Fundus photo.
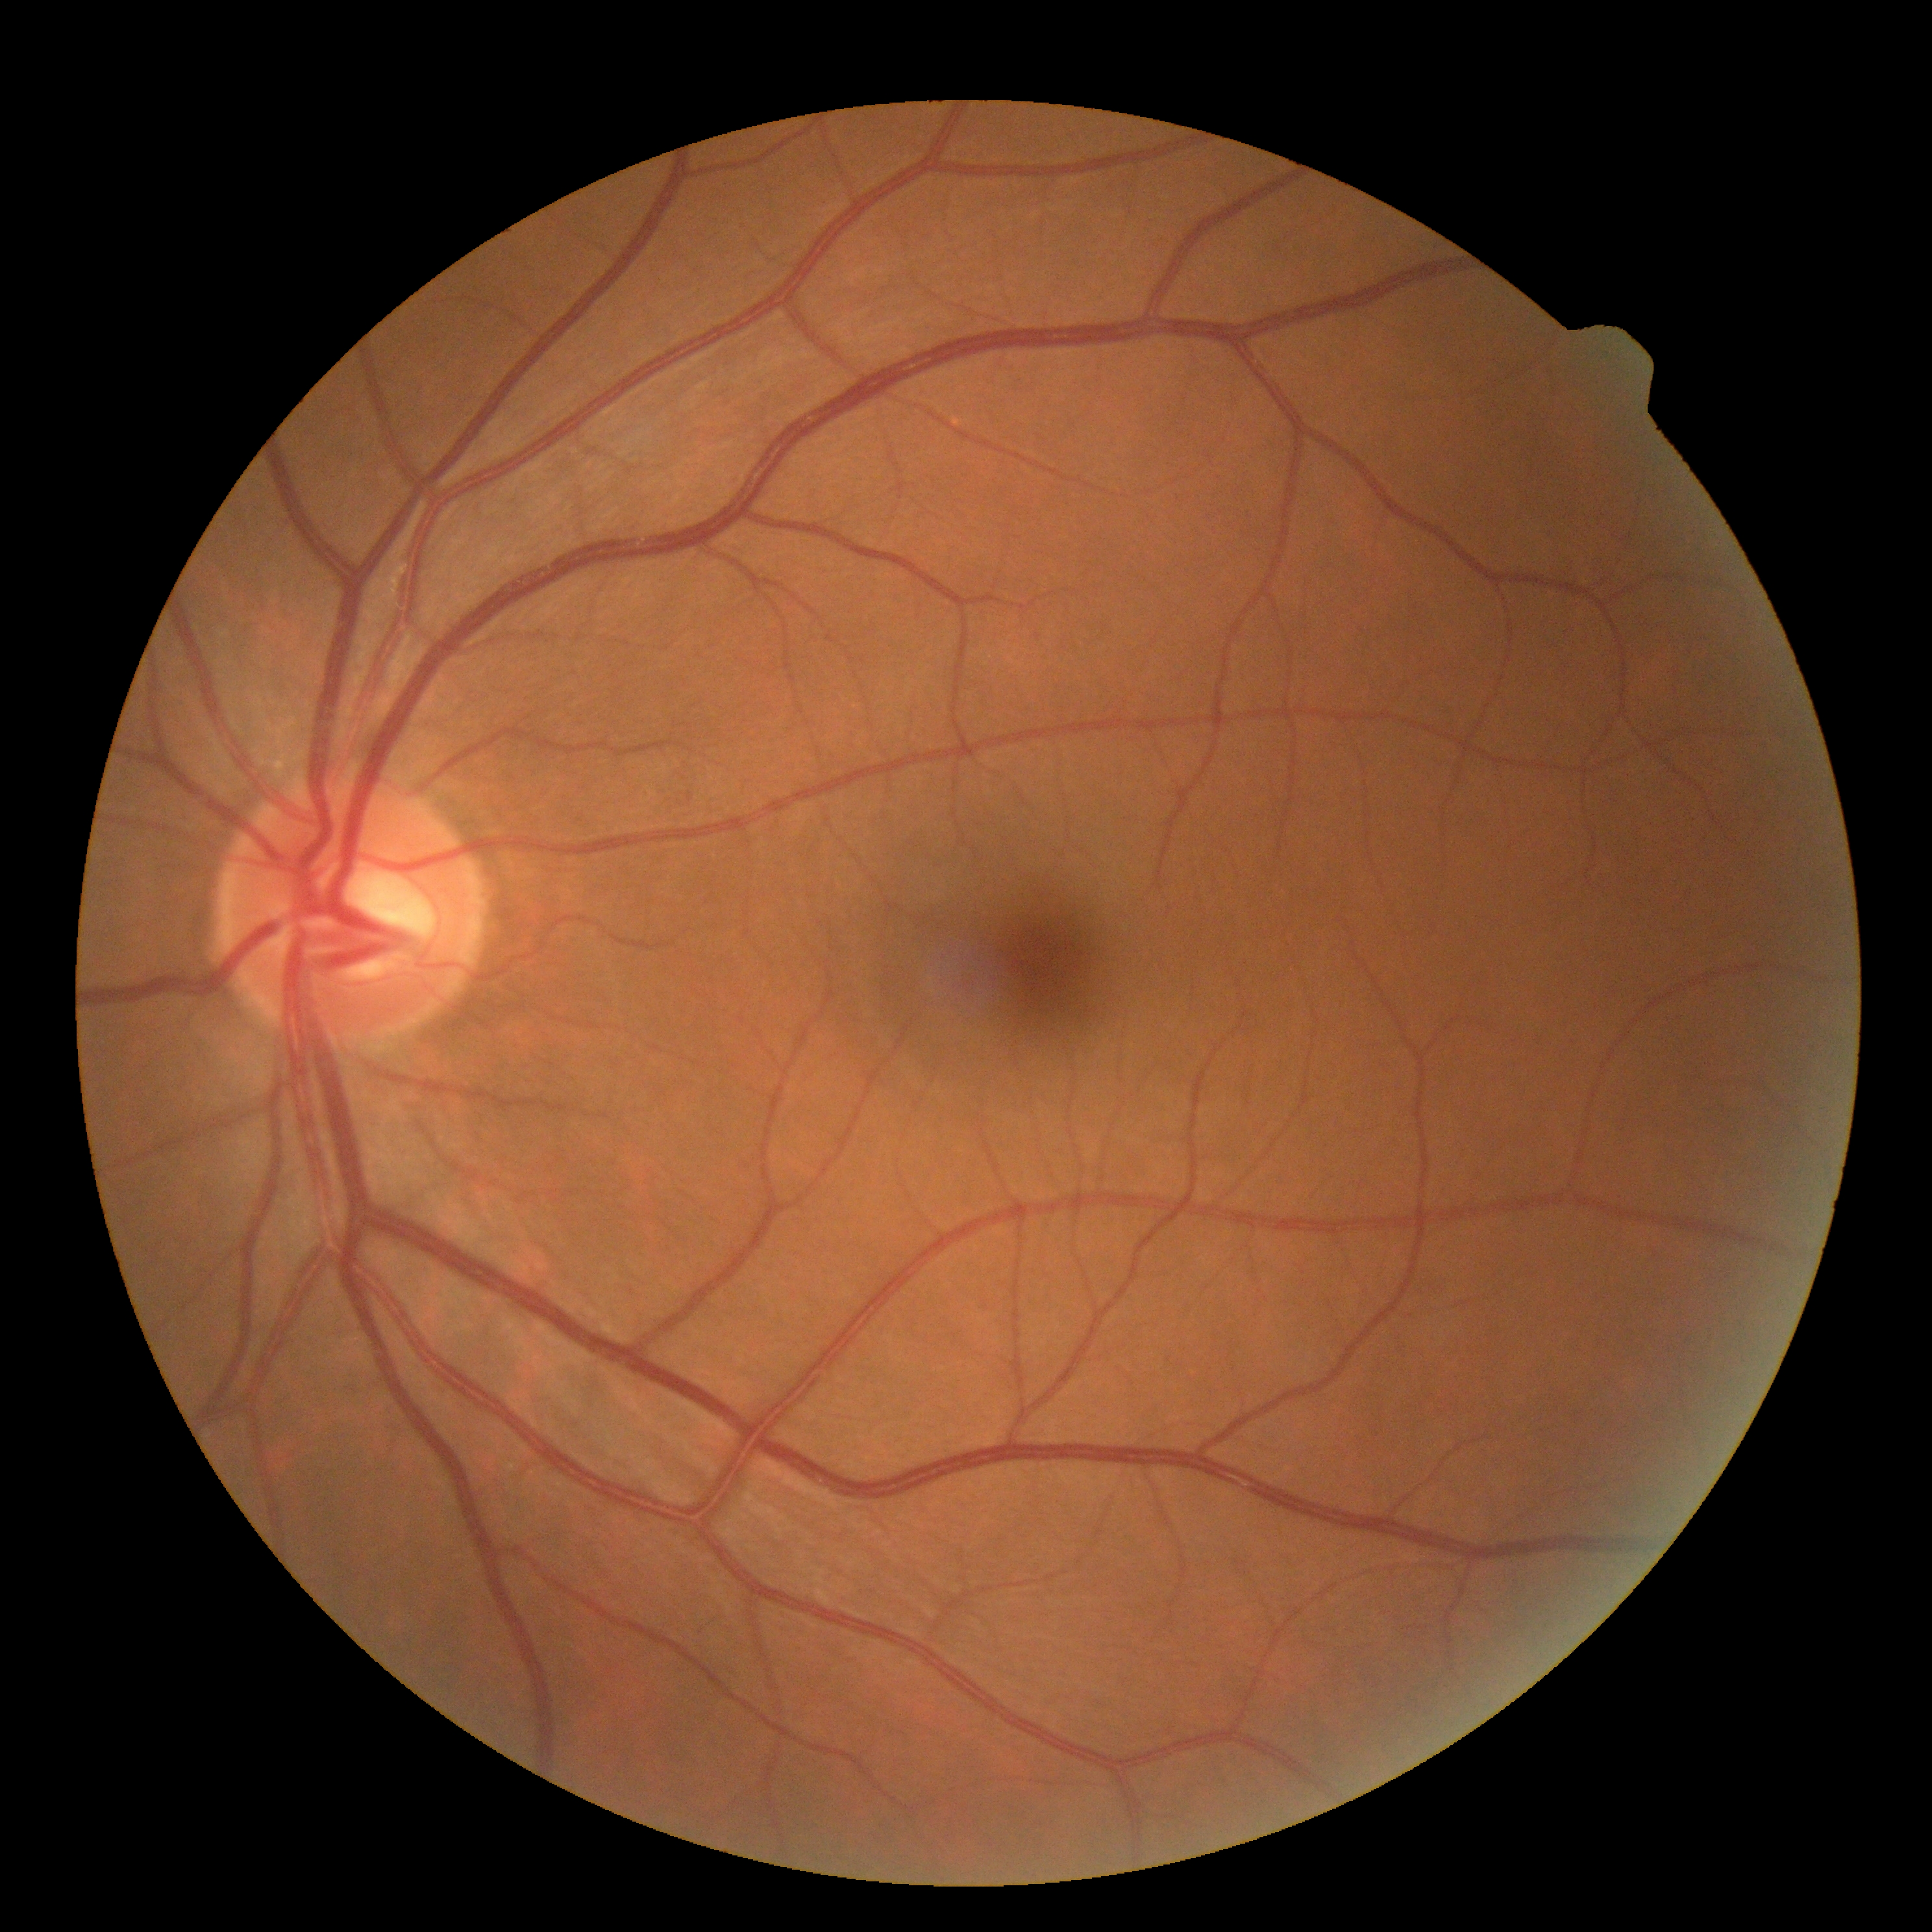 DR severity: no apparent diabetic retinopathy (grade 0).